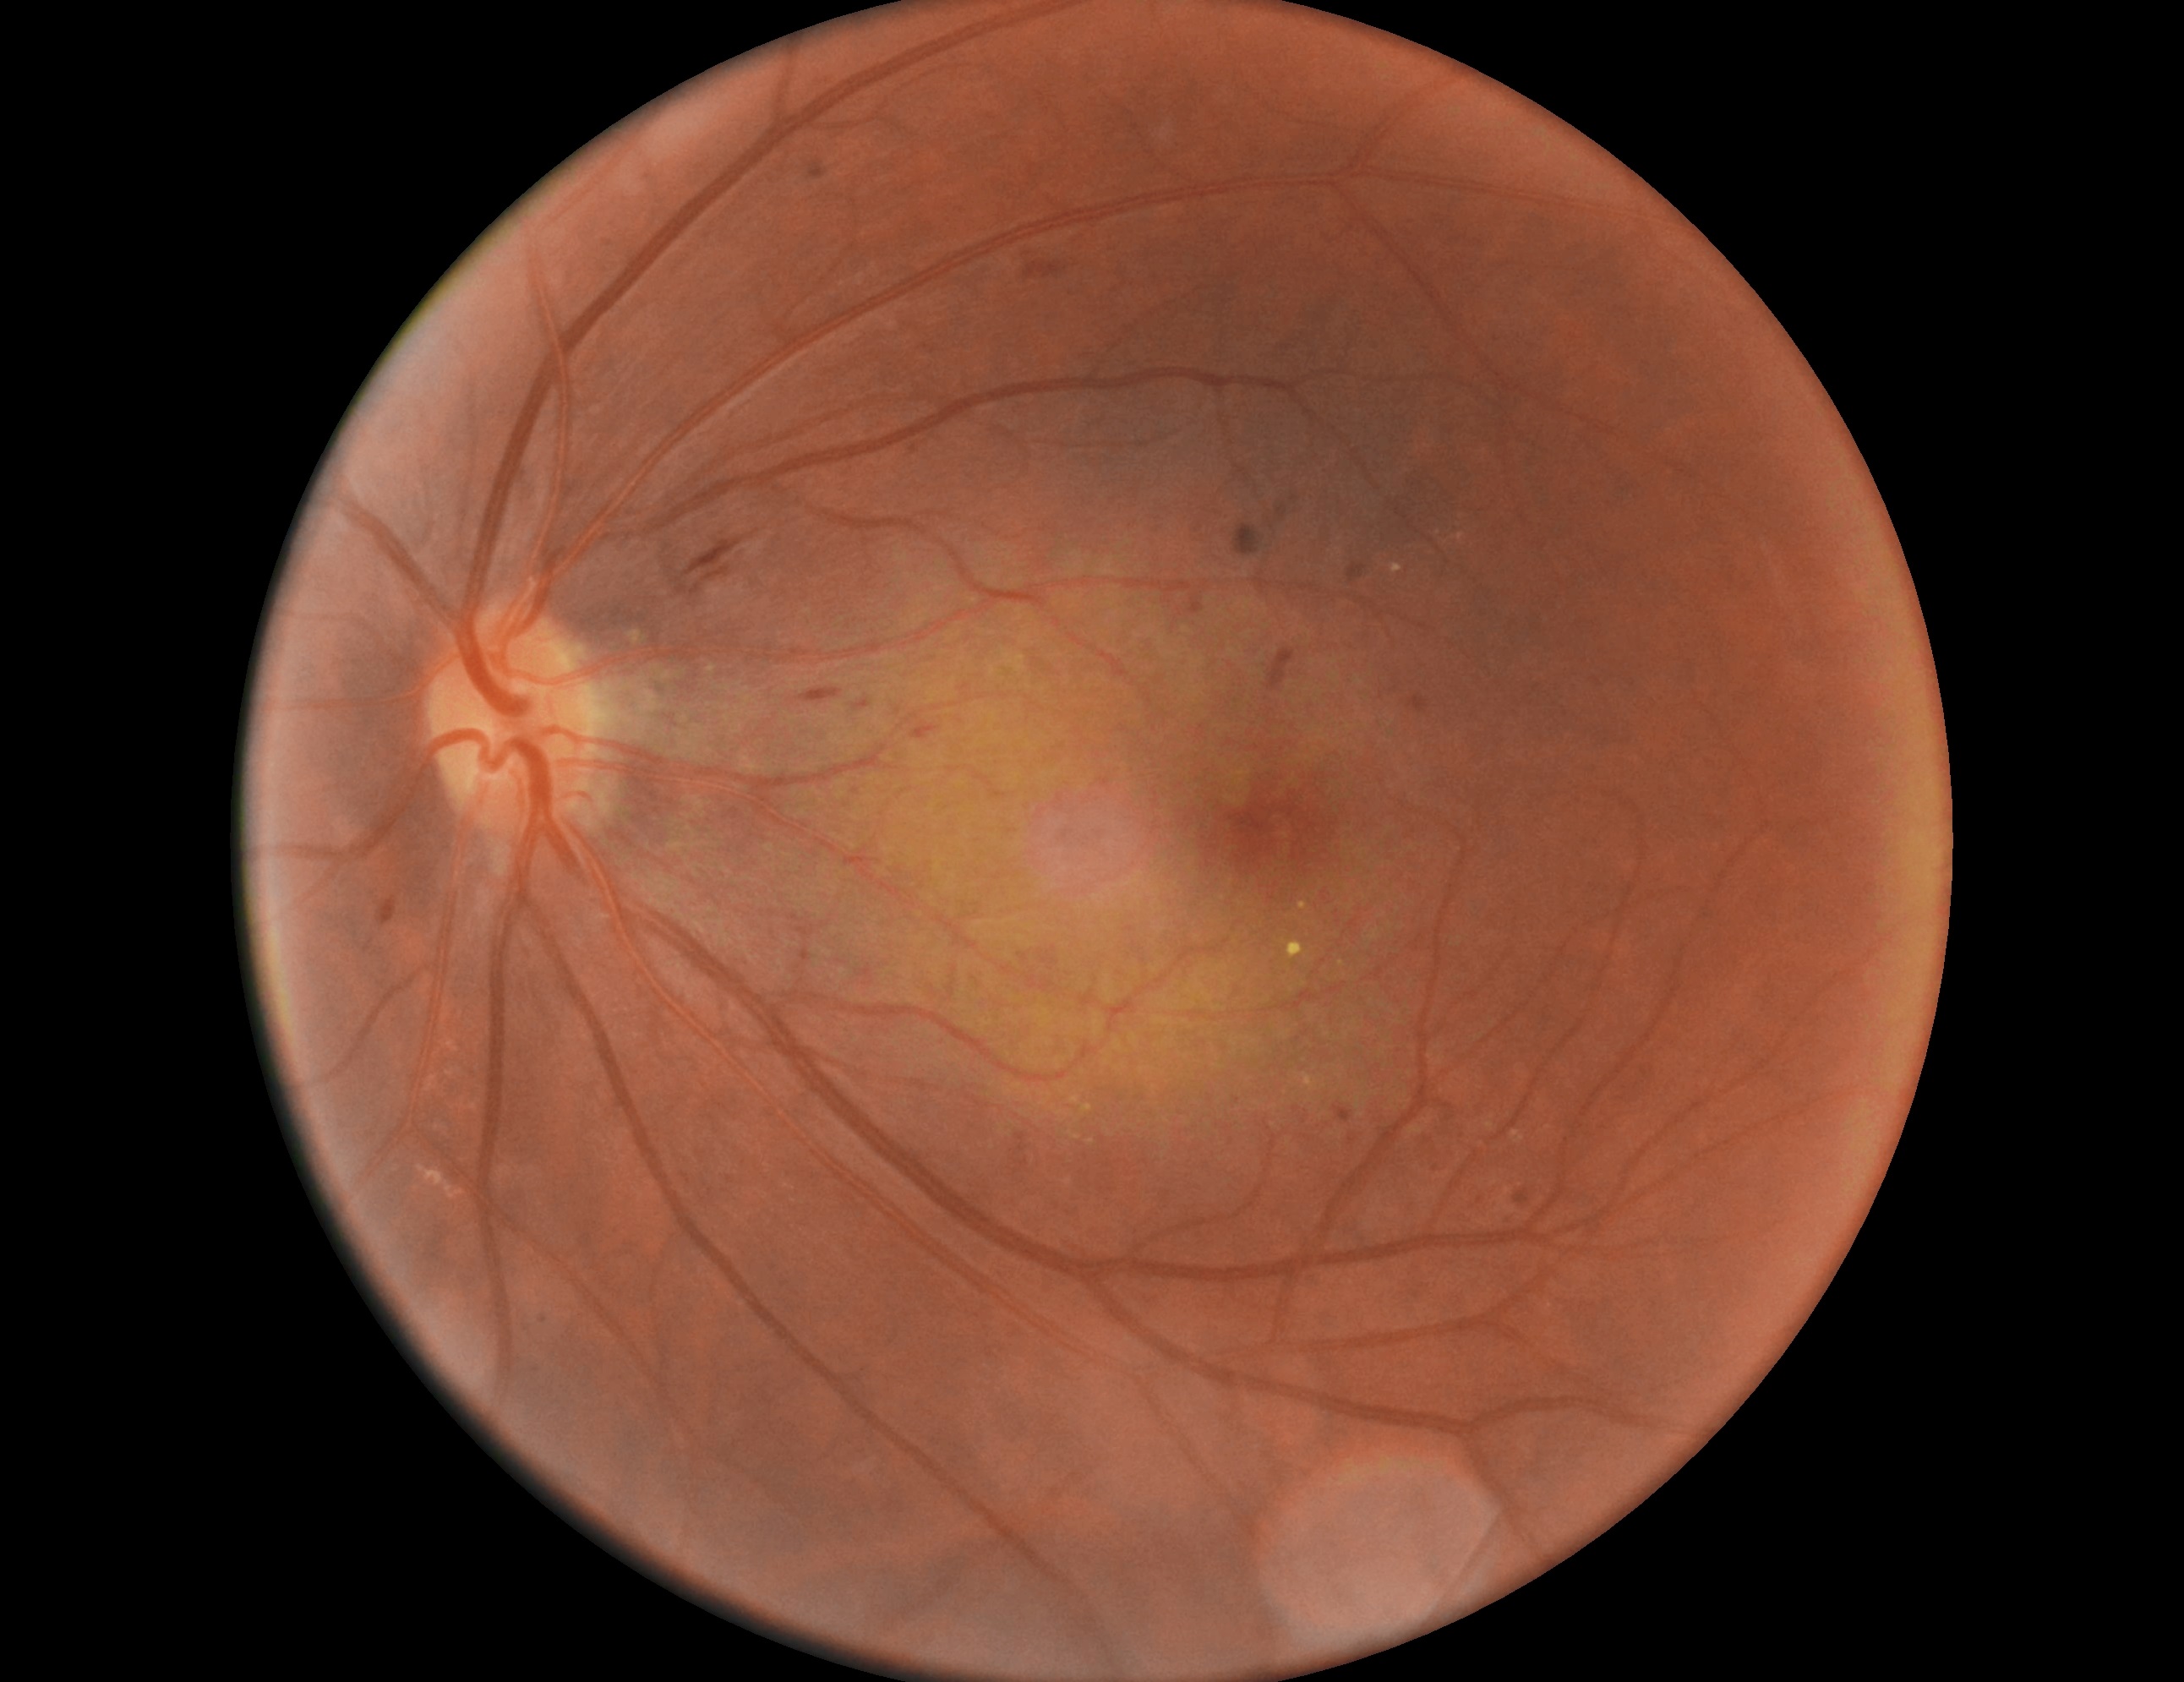

diabetic retinopathy grade: 2 — more than just microaneurysms but less than severe NPDR | DR class: non-proliferative diabetic retinopathy.